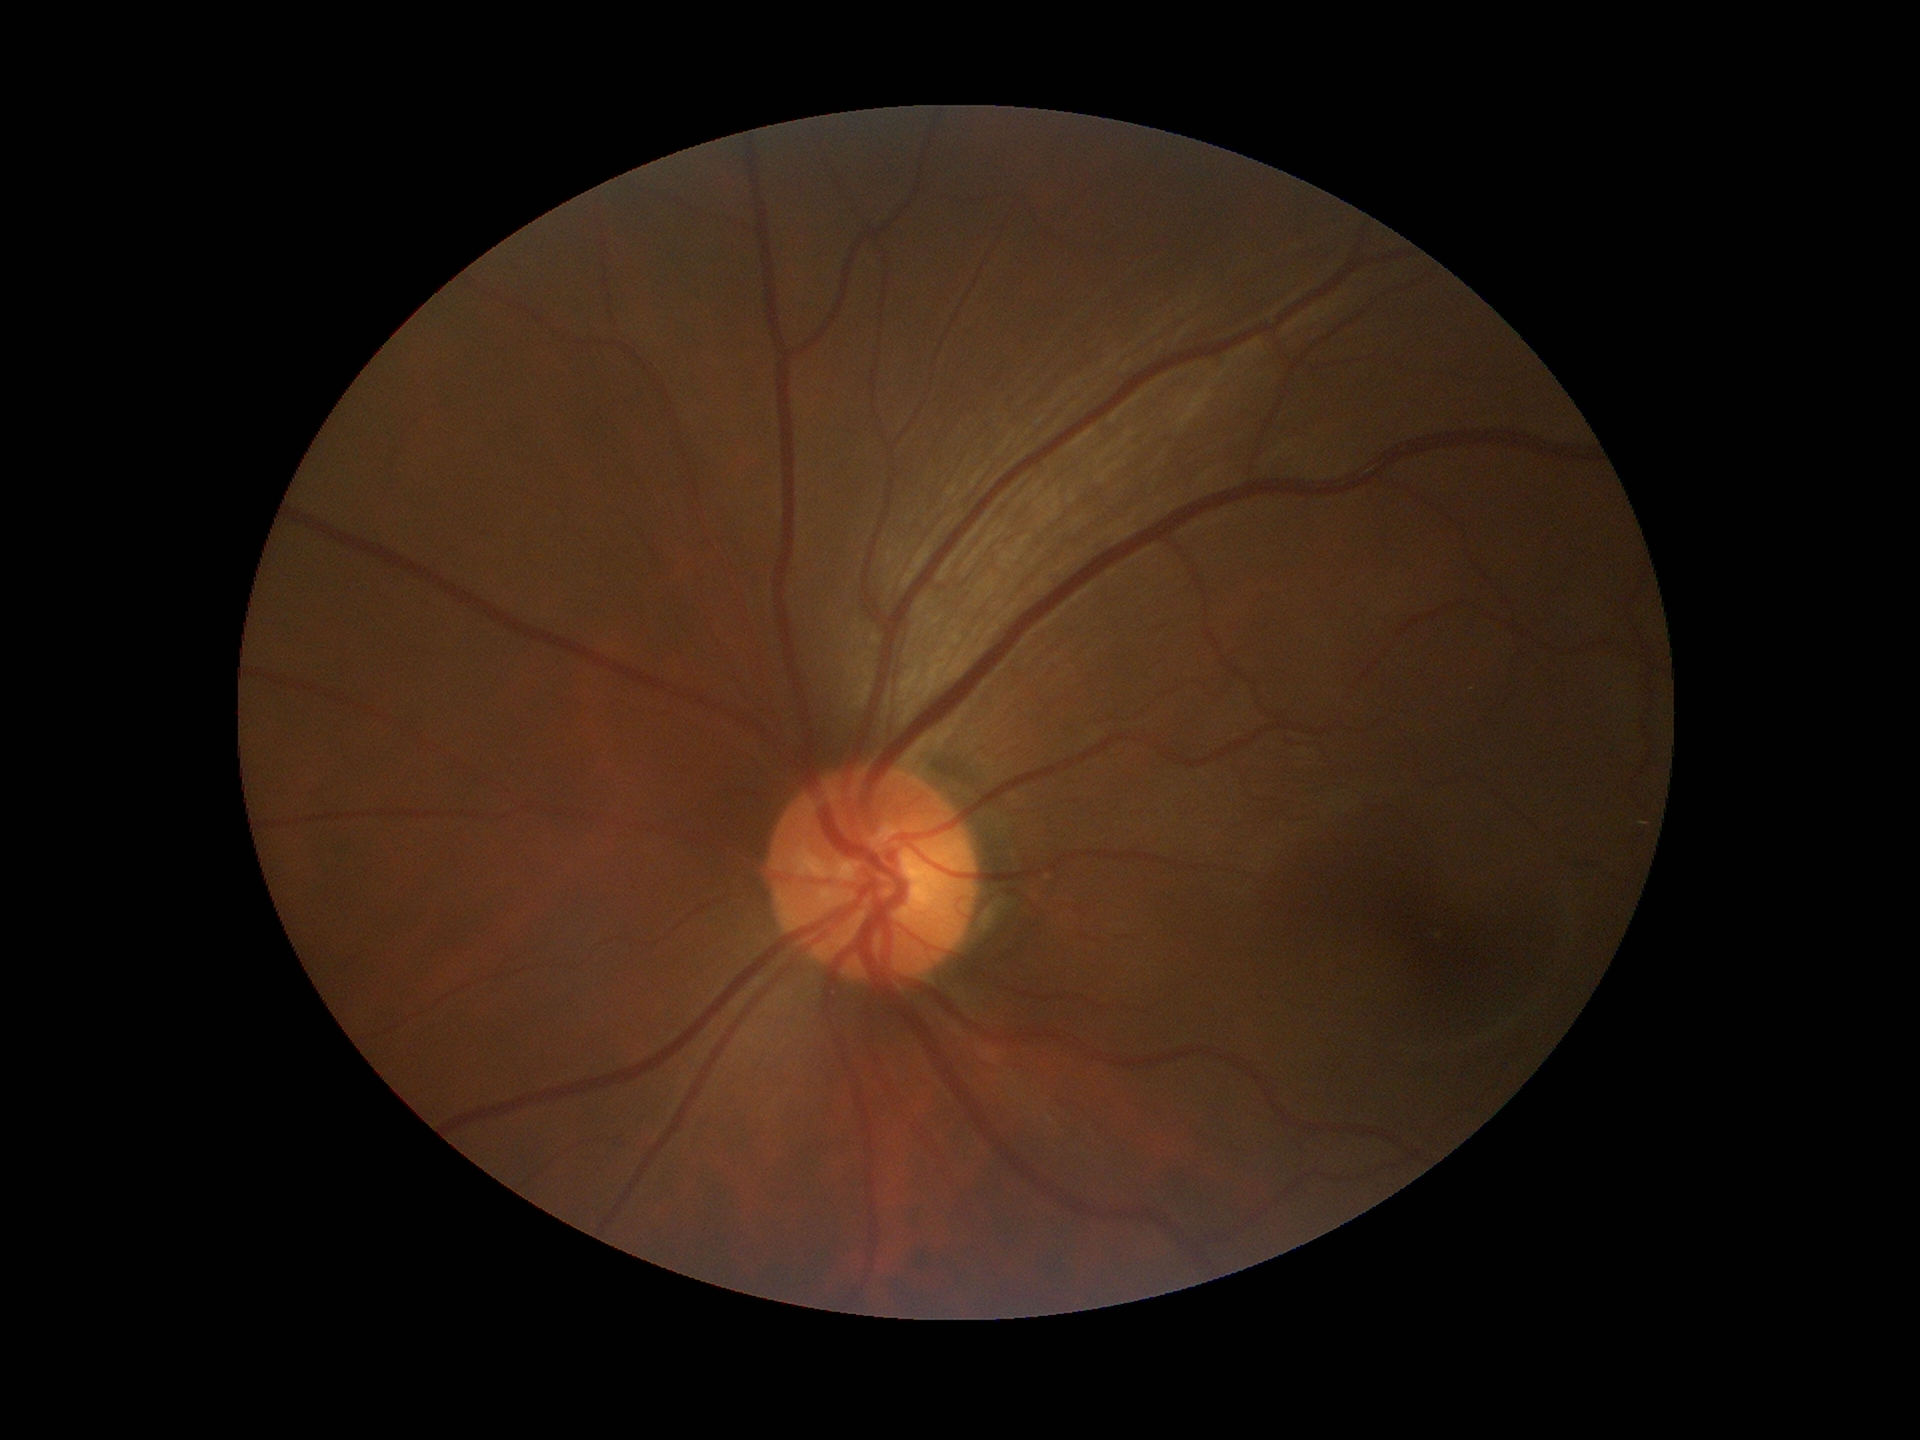 Glaucoma decision: negative. Vertical C/D ratio is 0.49. Horizontal CDR is 0.51.